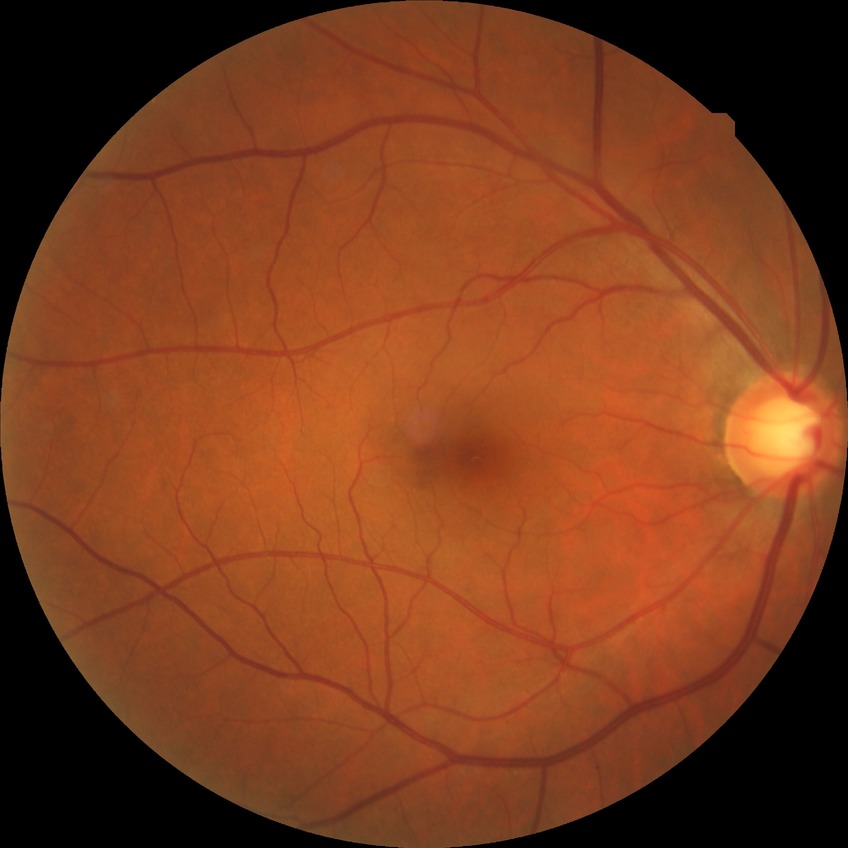
Davis DR grade: NDR.